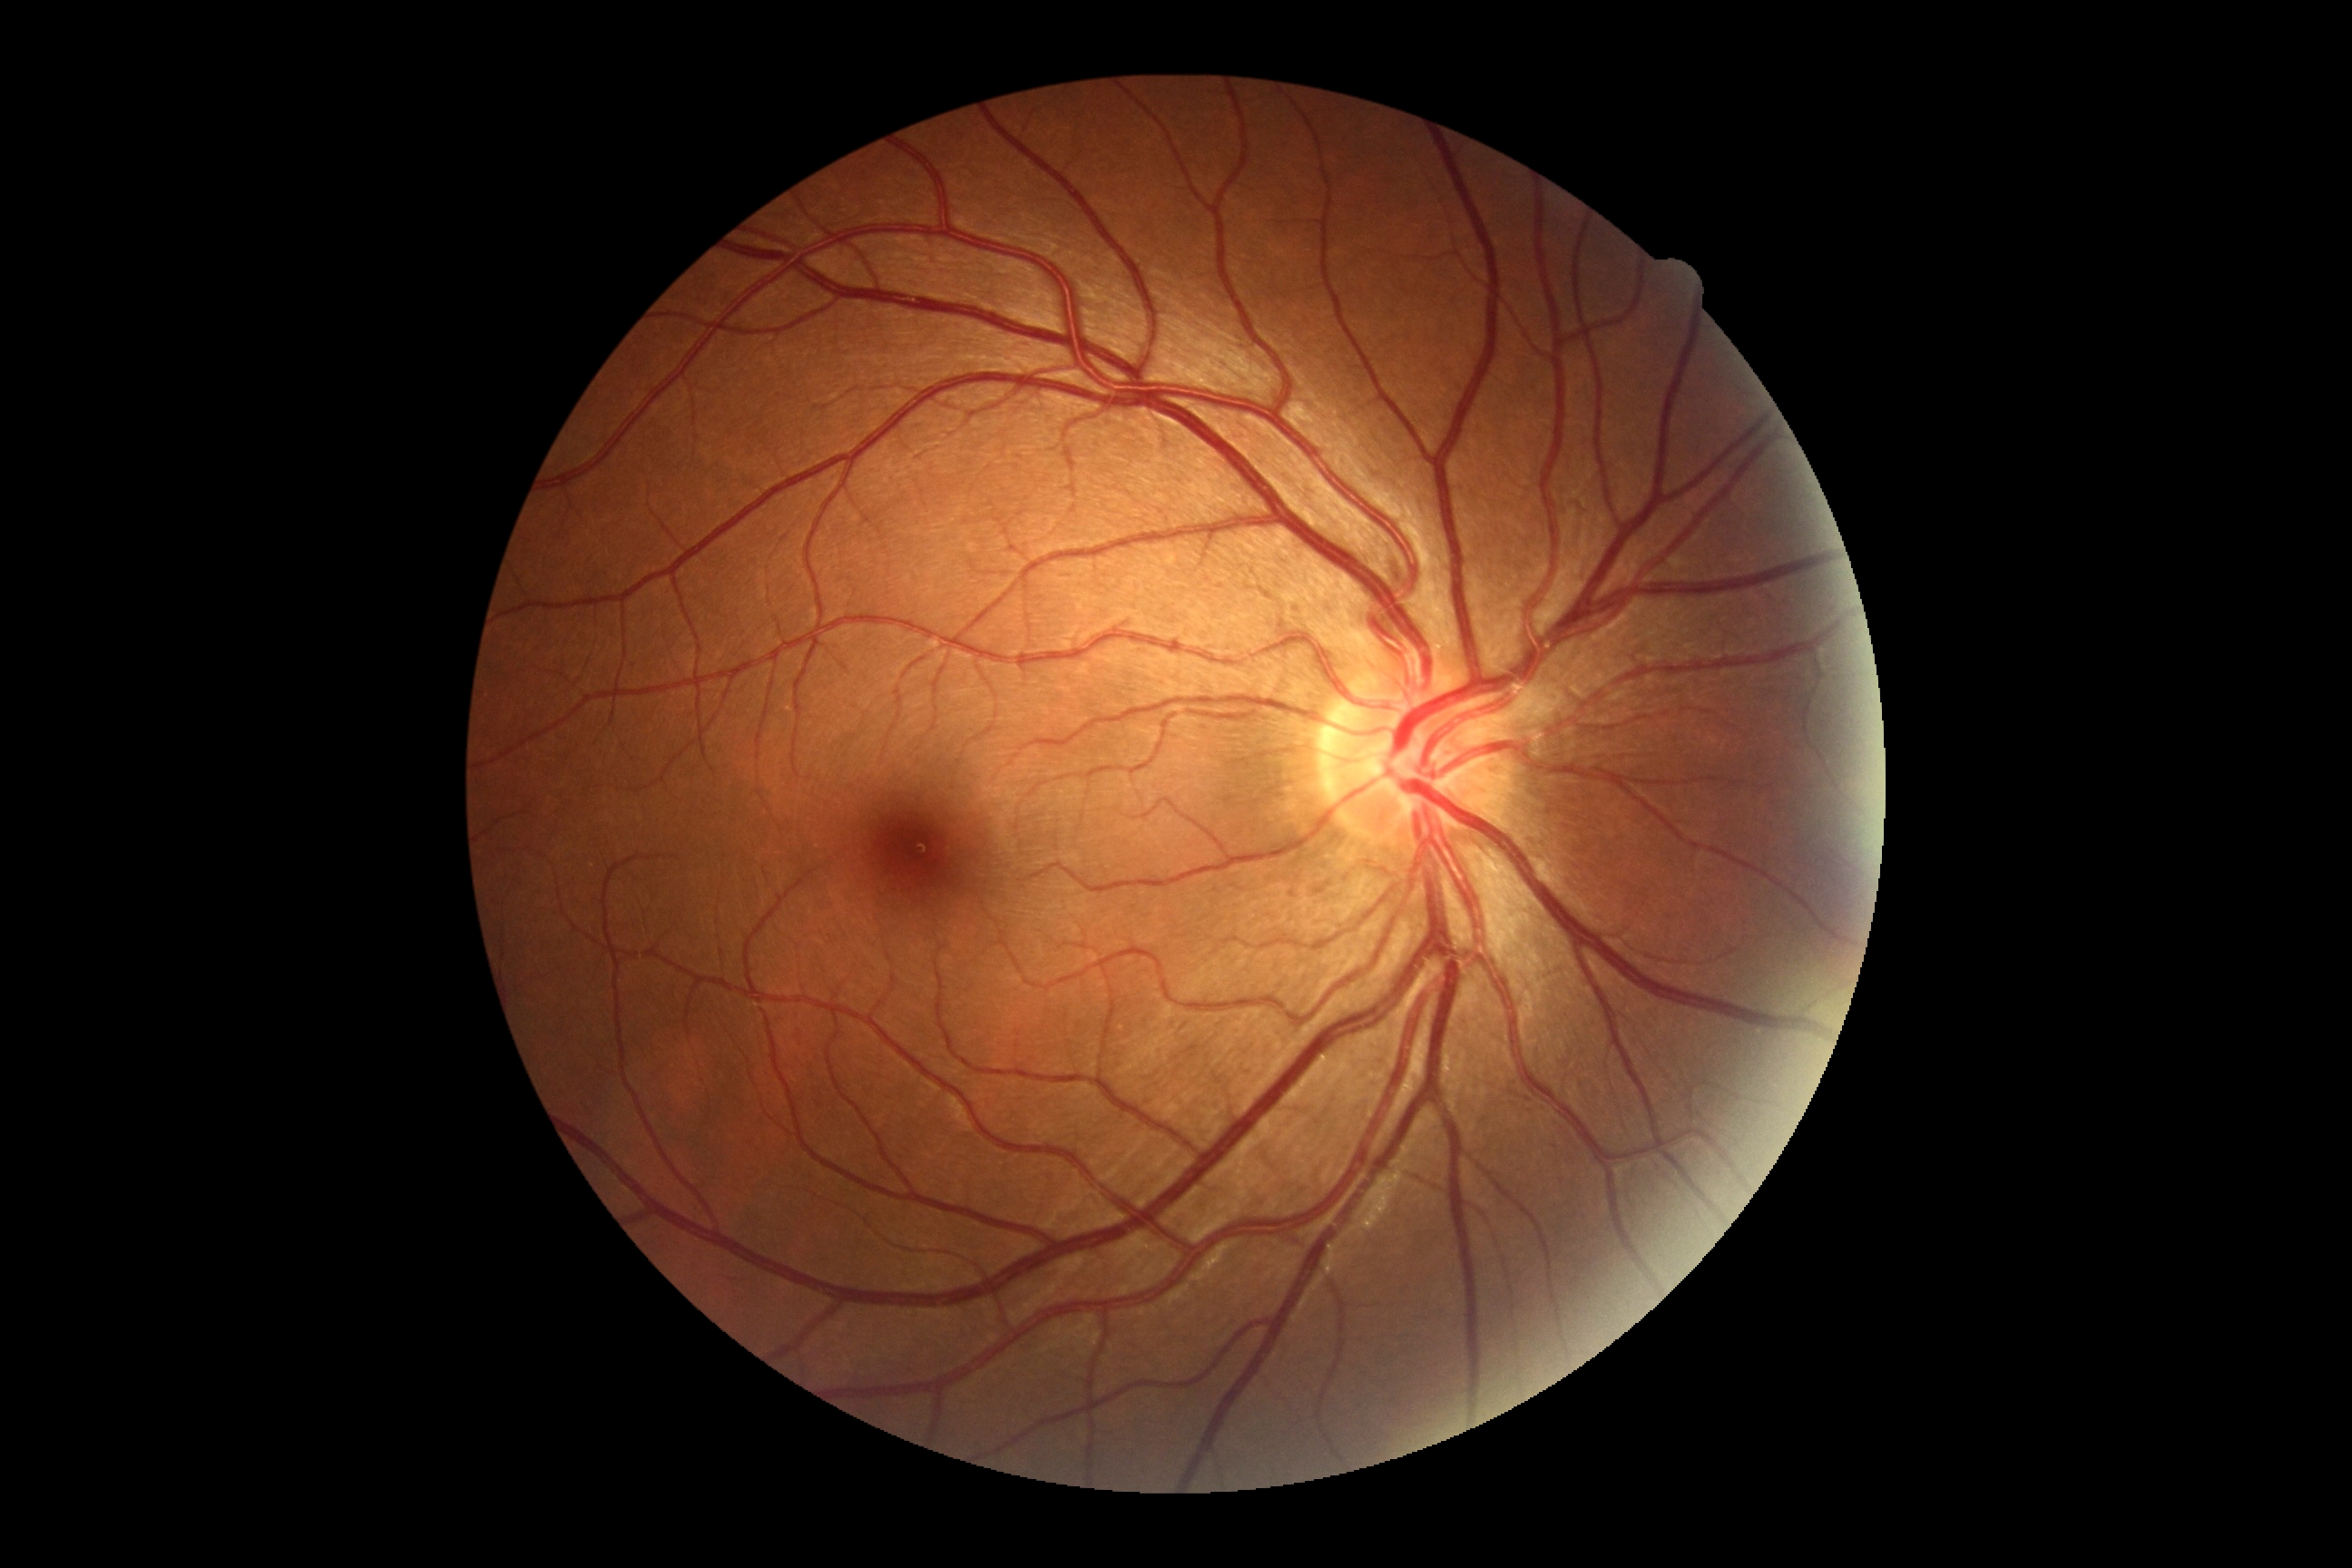

Findings:
- DR grade — 0